Infant wide-field fundus photograph. 1240 by 1240 pixels:
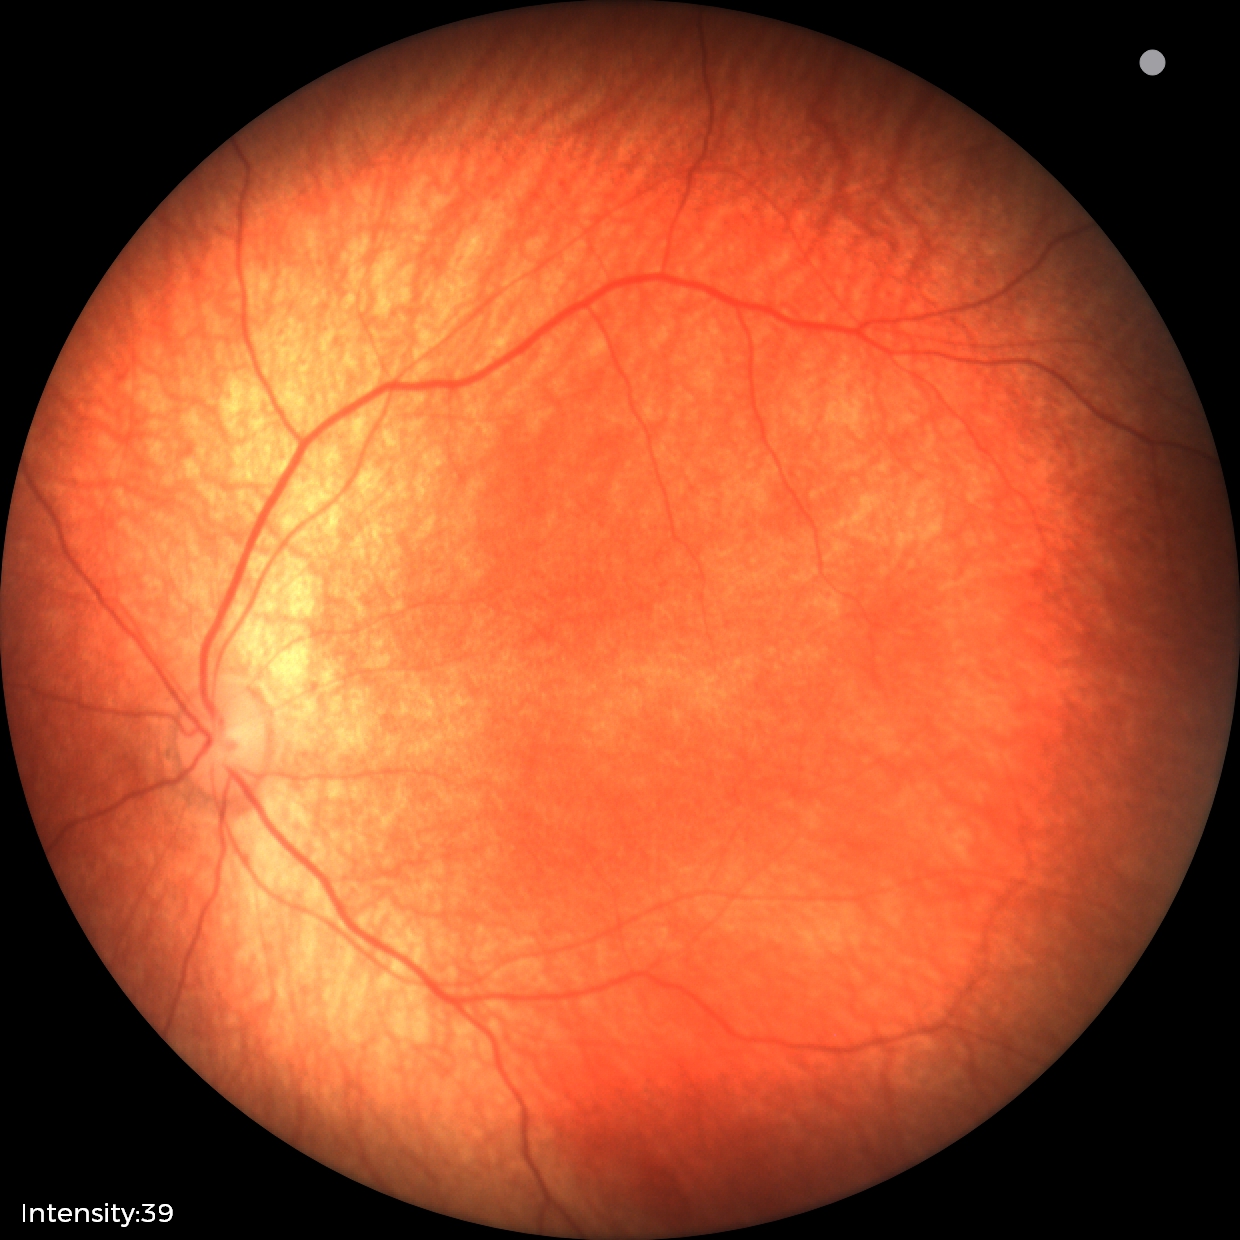 Screening diagnosis: no pathology identified.